45 degree fundus photograph. Modified Davis classification. NIDEK AFC-230:
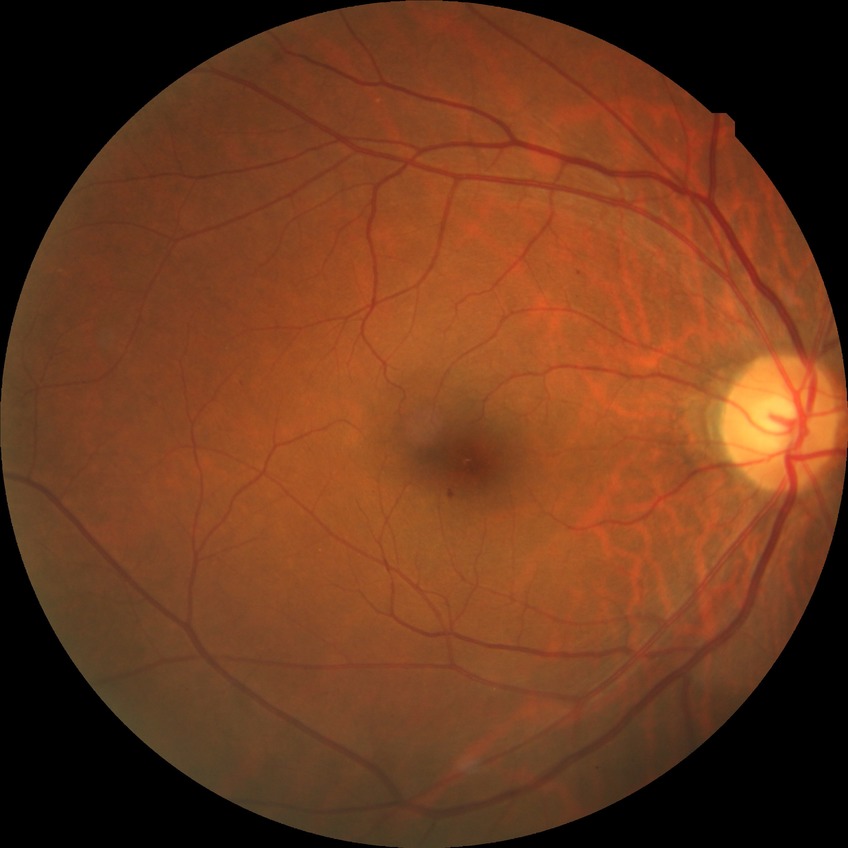

Modified Davis grading is simple diabetic retinopathy.